Image size 512x512.
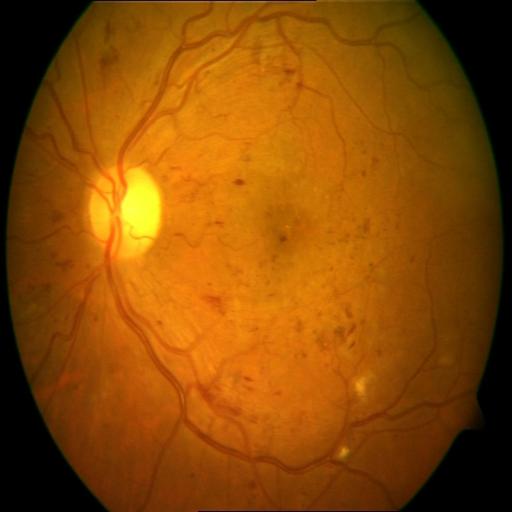

Pathology: hemorrhagic retinopathy; exudation.